Graded on the modified Davis scale
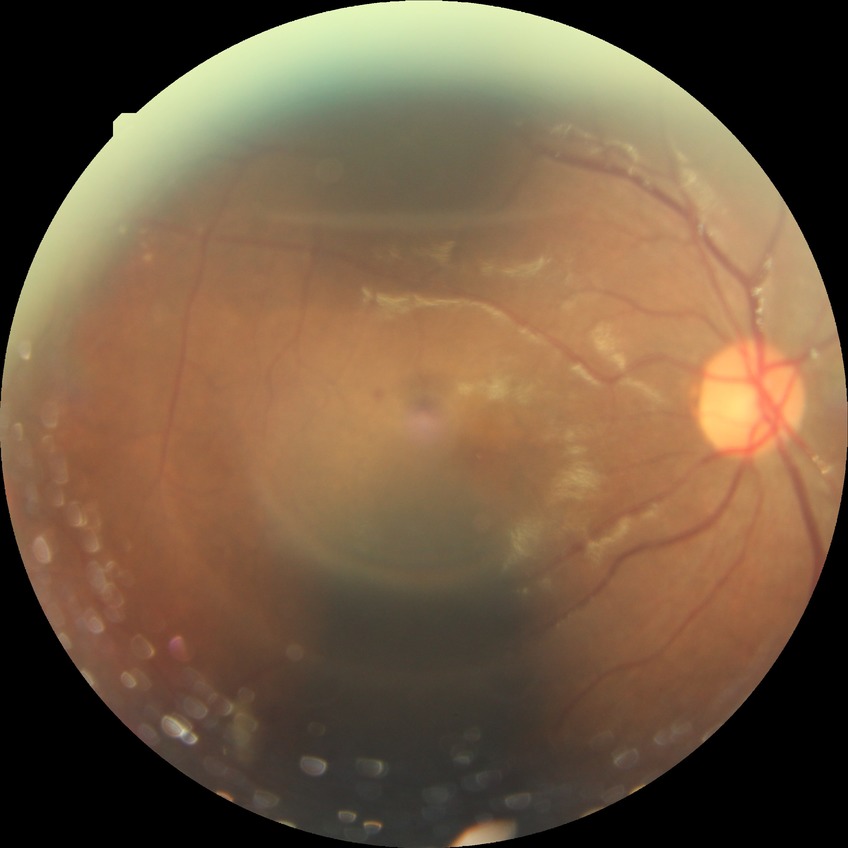

Modified Davis classification: pre-proliferative diabetic retinopathy.